Fundus photo · 2352x1568 · 45° FOV — 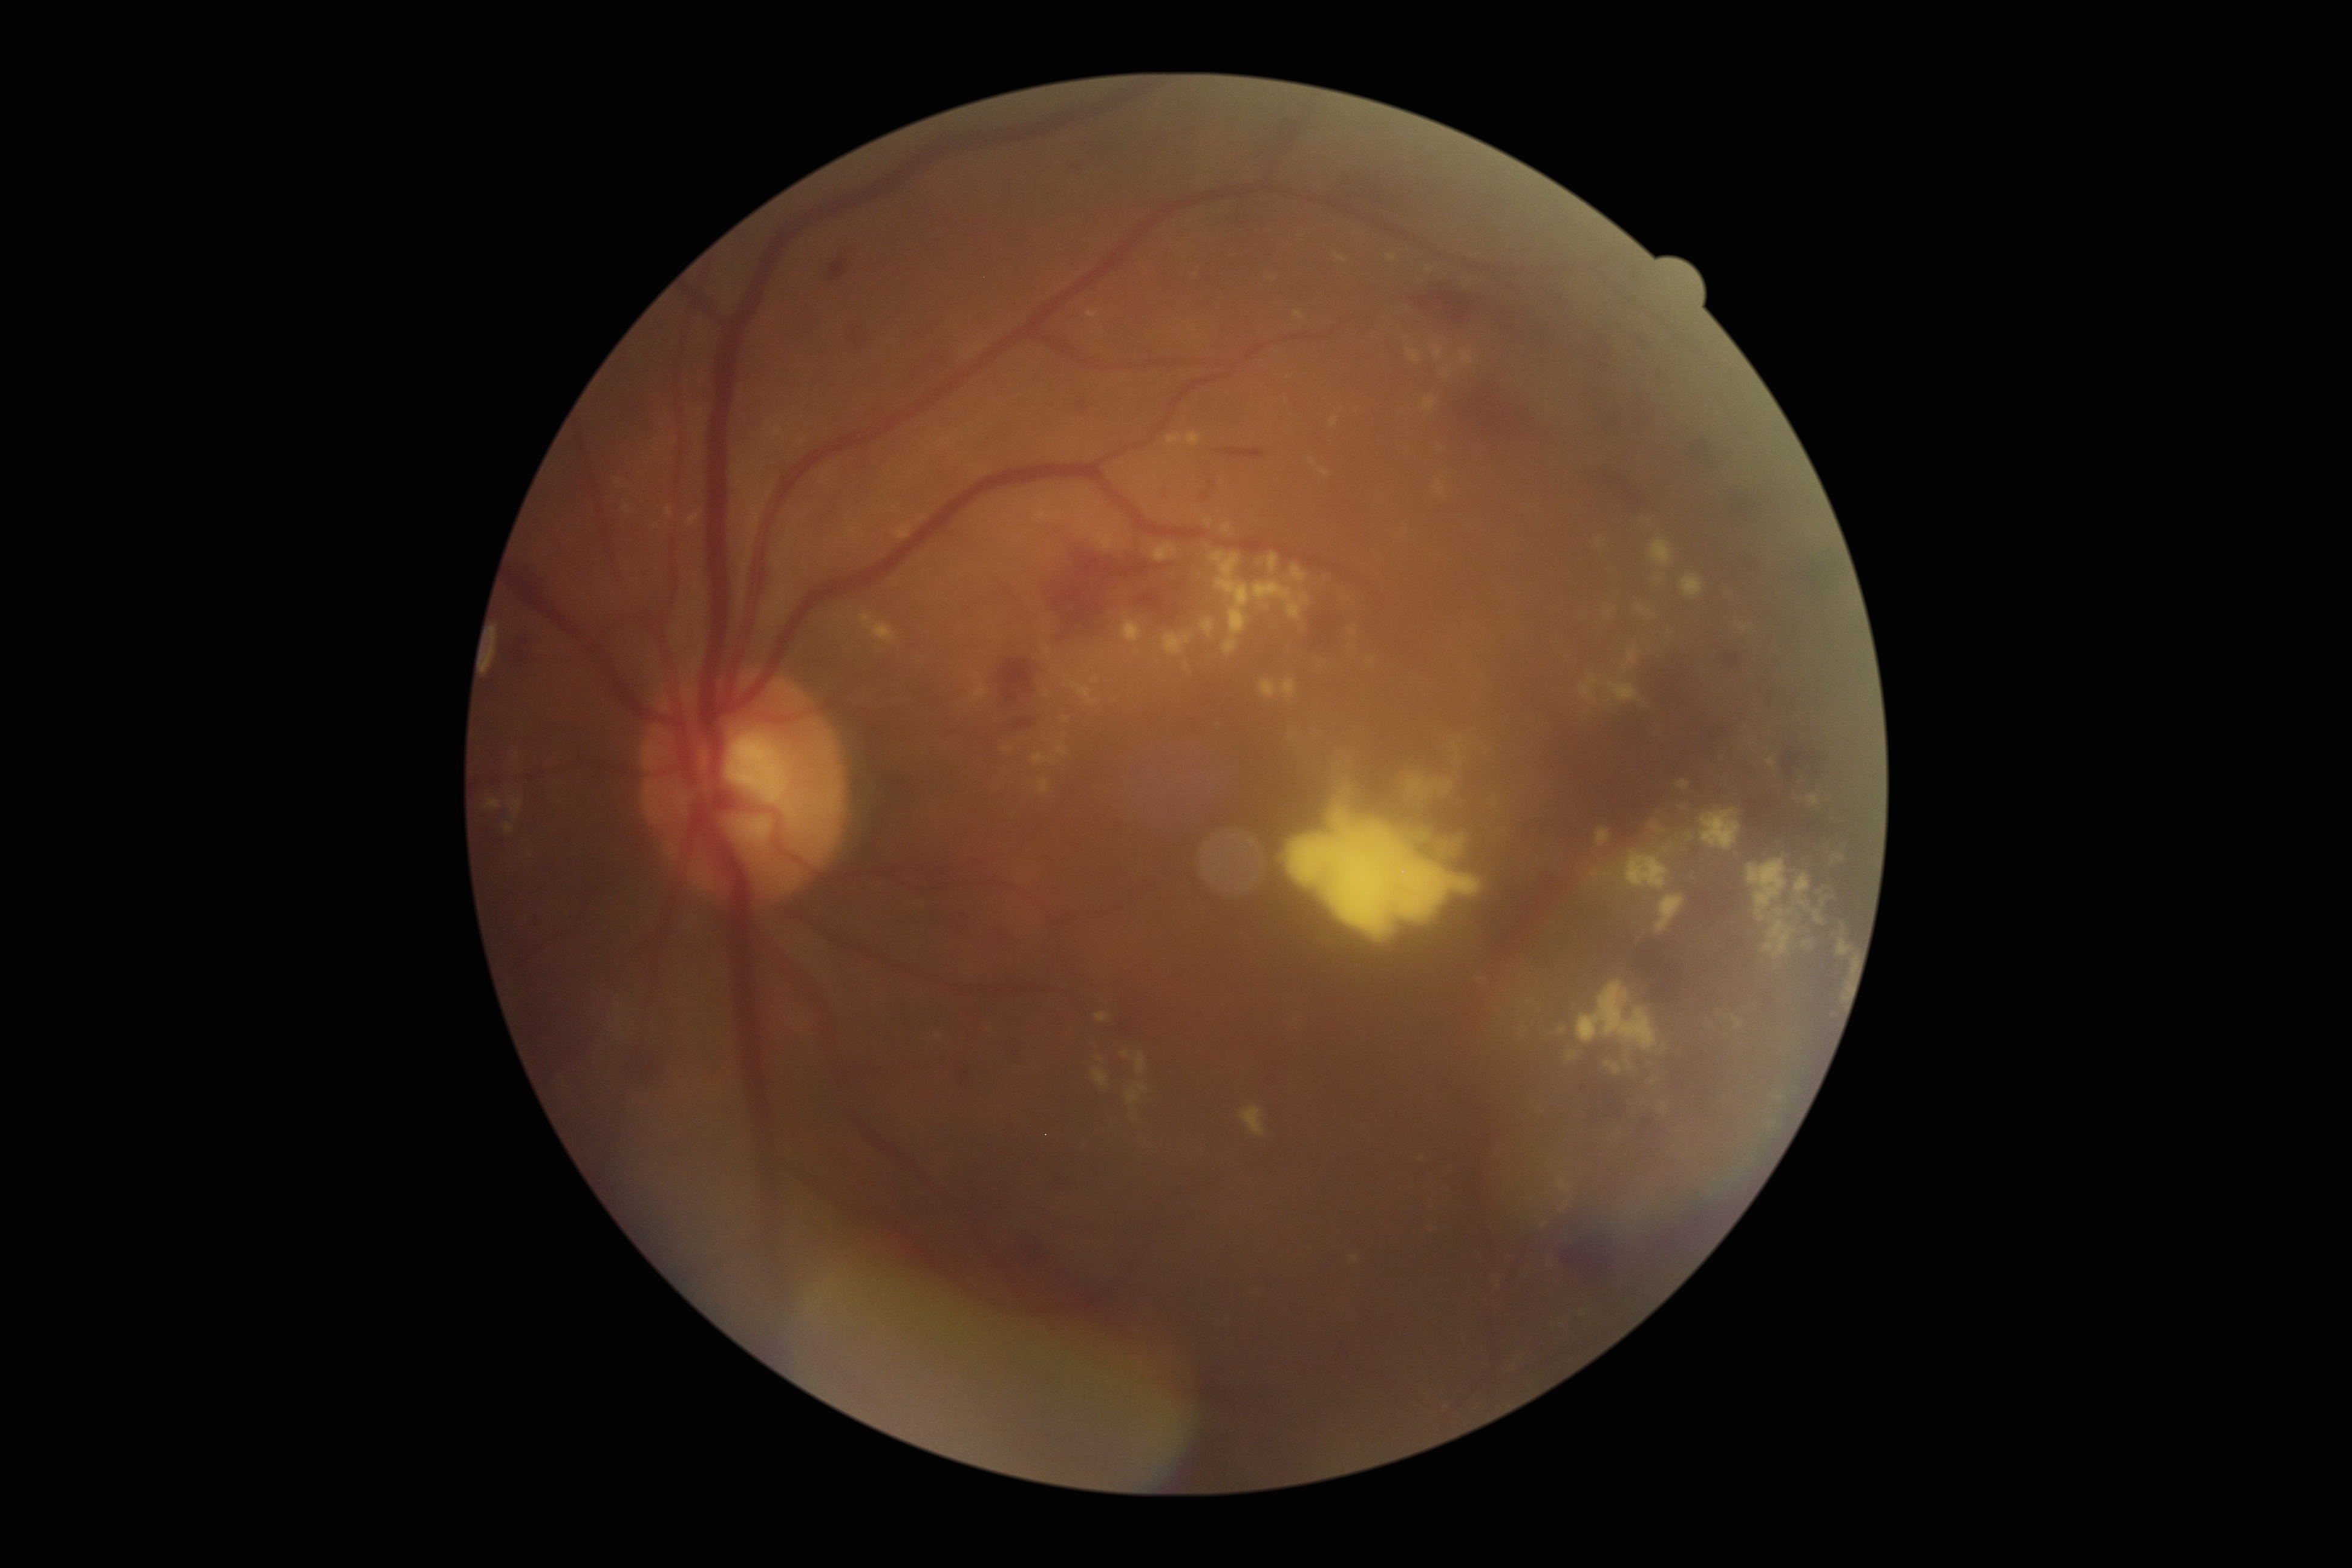

DR is grade 3 (severe NPDR) — more than 20 intraretinal hemorrhages in each of 4 quadrants, definite venous beading in 2 or more quadrants, or prominent intraretinal microvascular abnormalities in 1 or more quadrants, with no signs of proliferative retinopathy.